RetCam wide-field infant fundus image. 1440 by 1080 pixels.
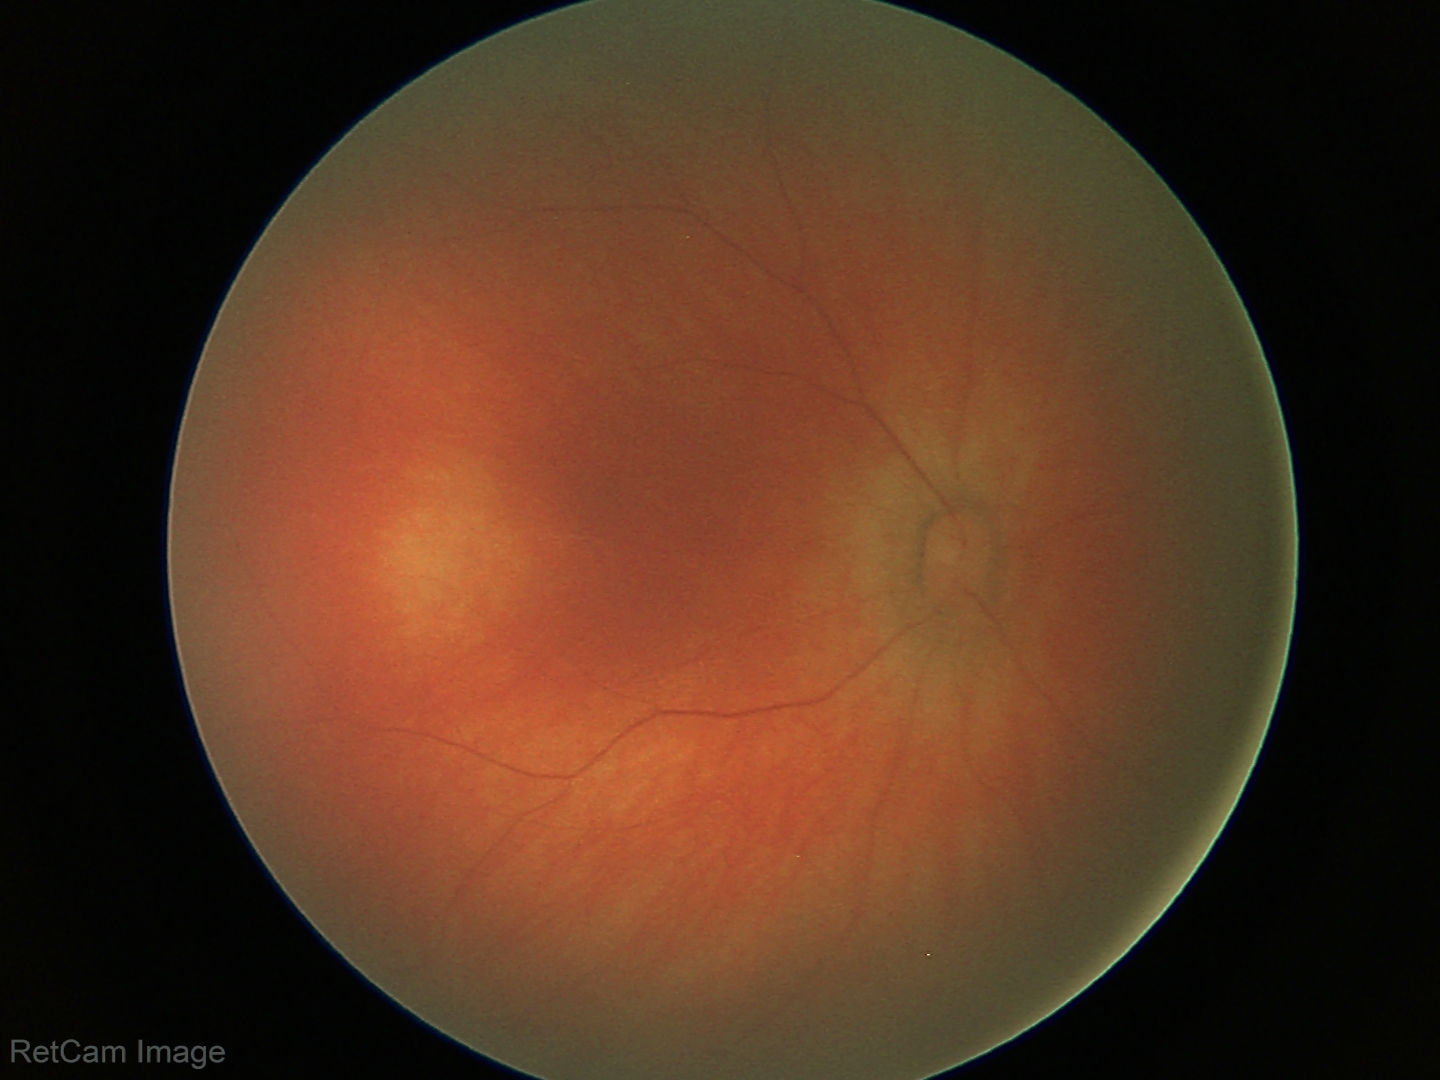 Physiological retinal appearance for postconceptual age.